FOV: 45 degrees. Fundus photo:
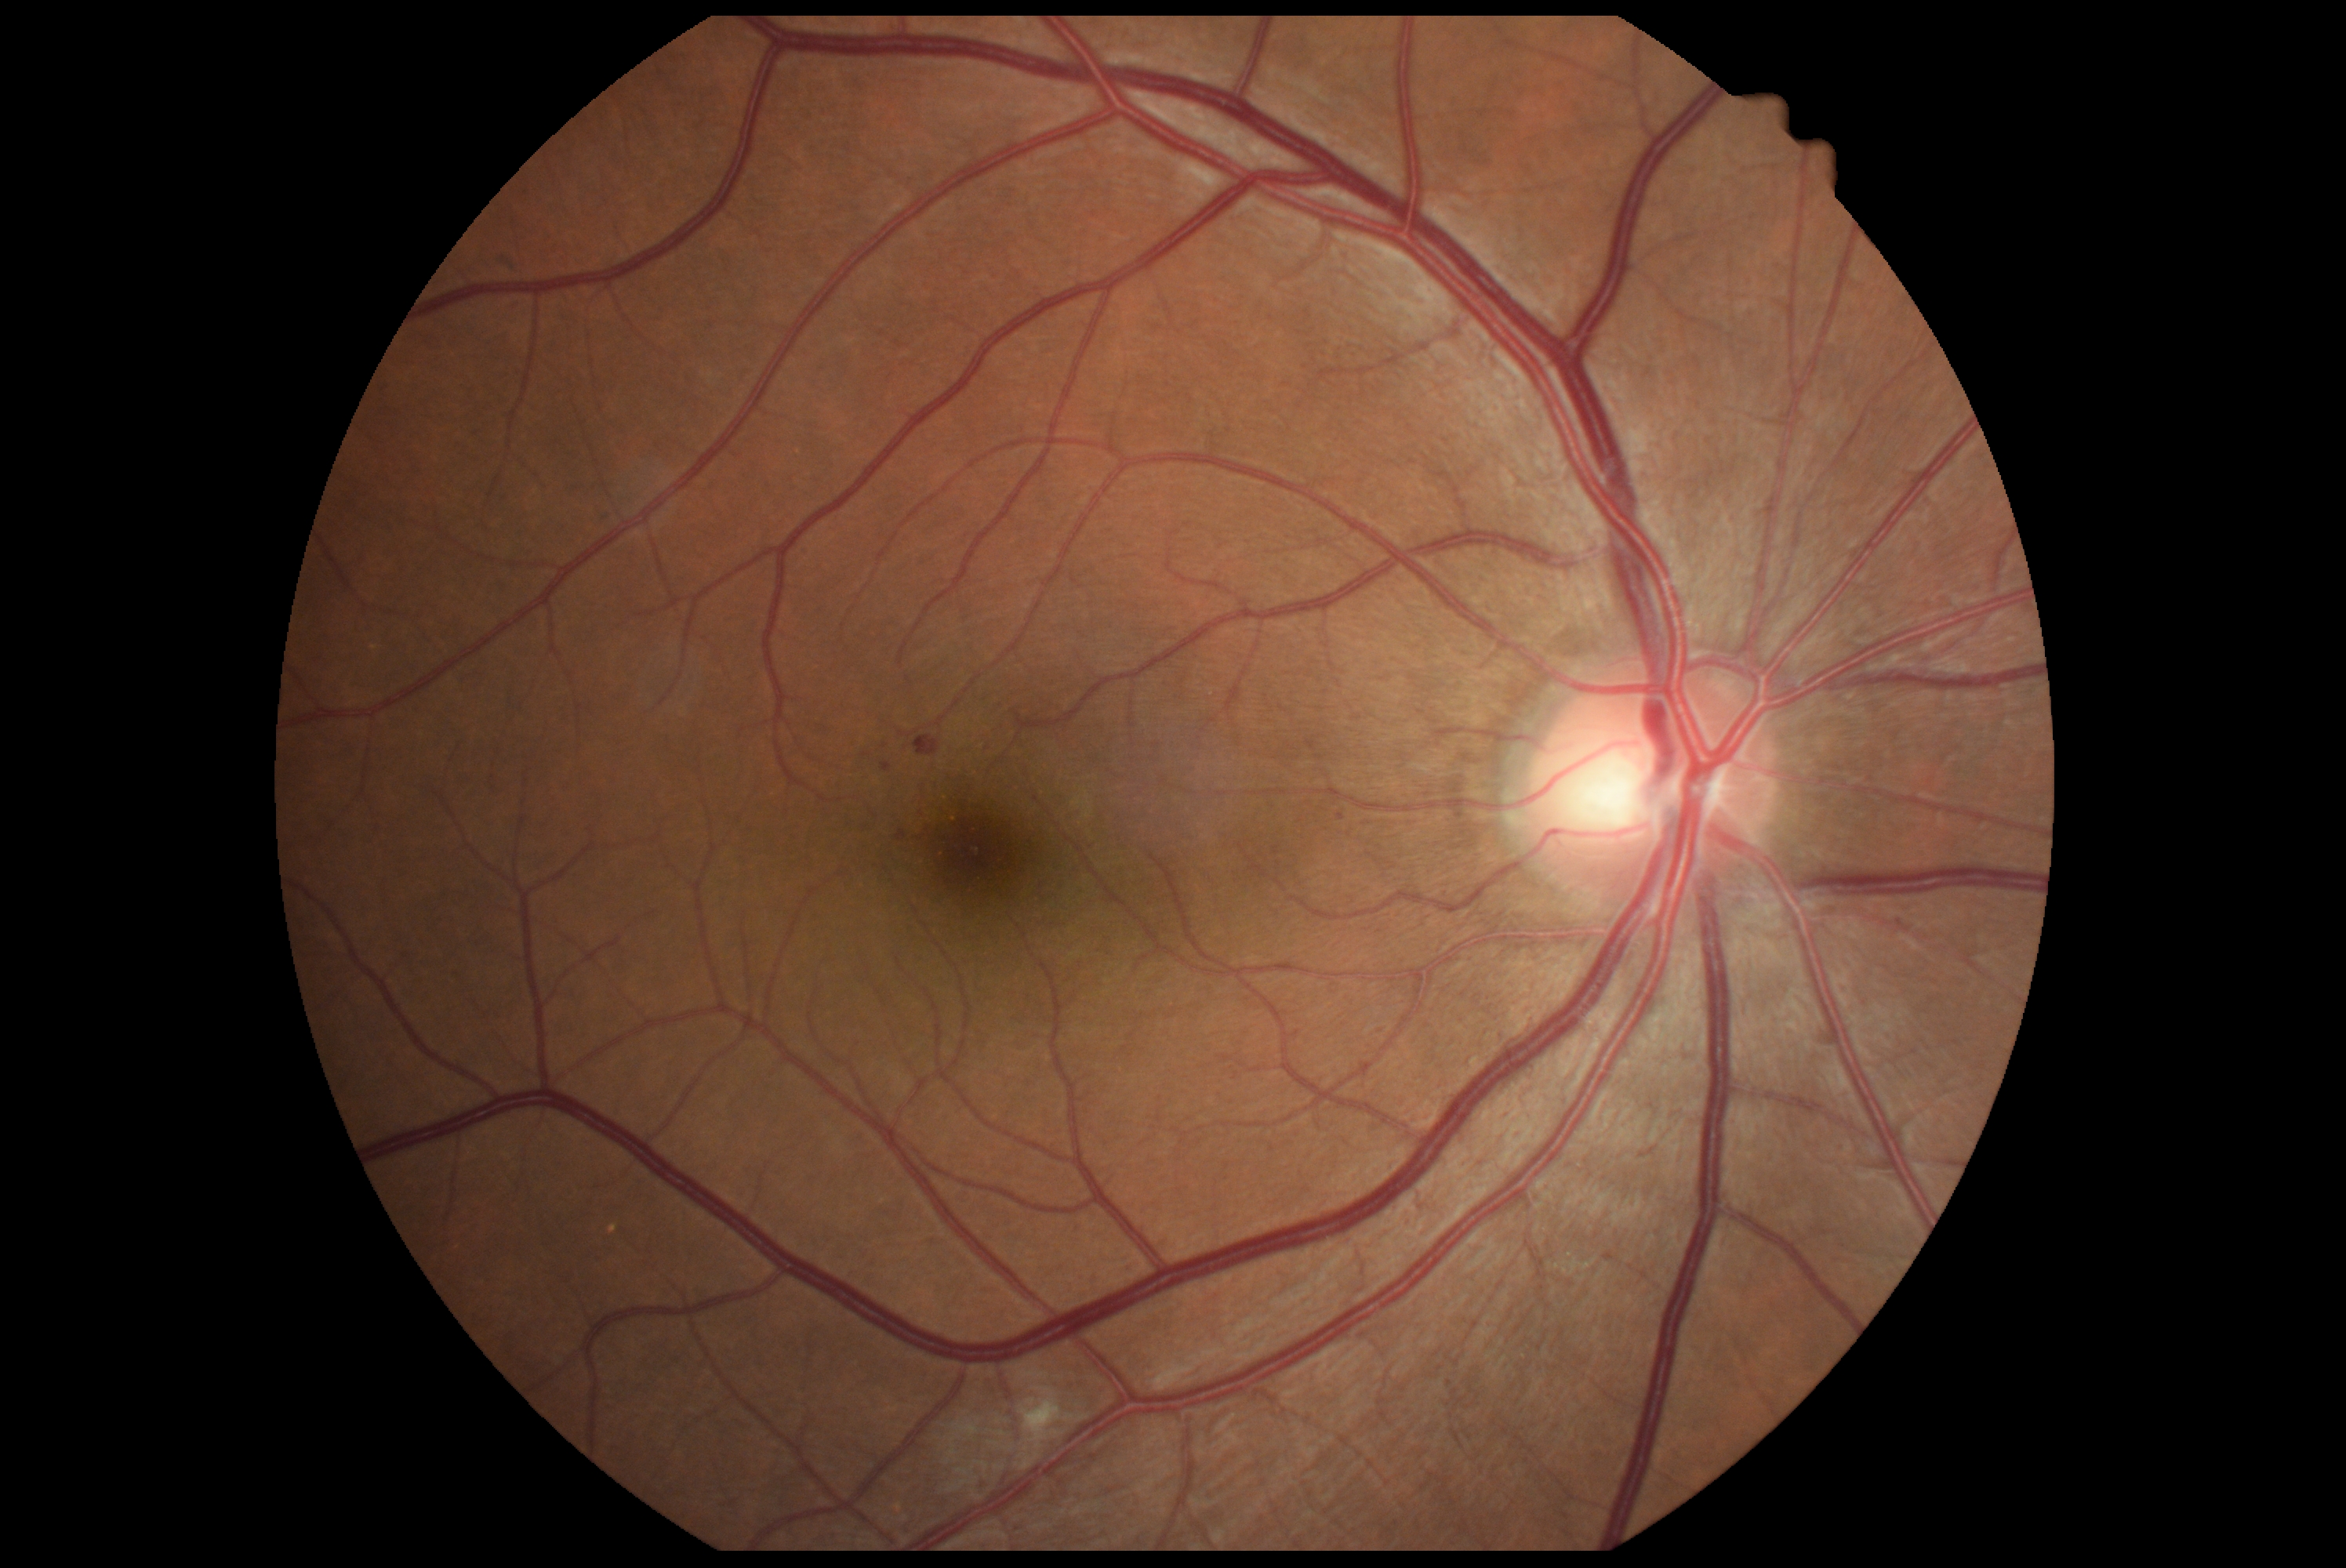

diabetic retinopathy grade=2/4.